45° field of view; nonmydriatic
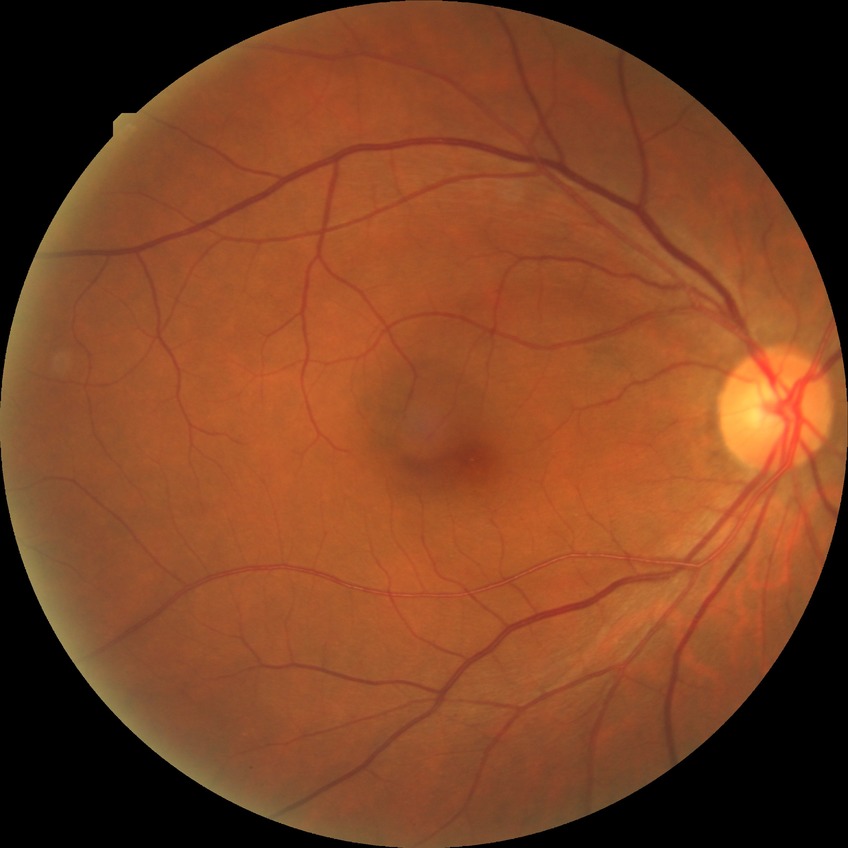

Diabetic retinopathy (DR): NDR (no diabetic retinopathy).